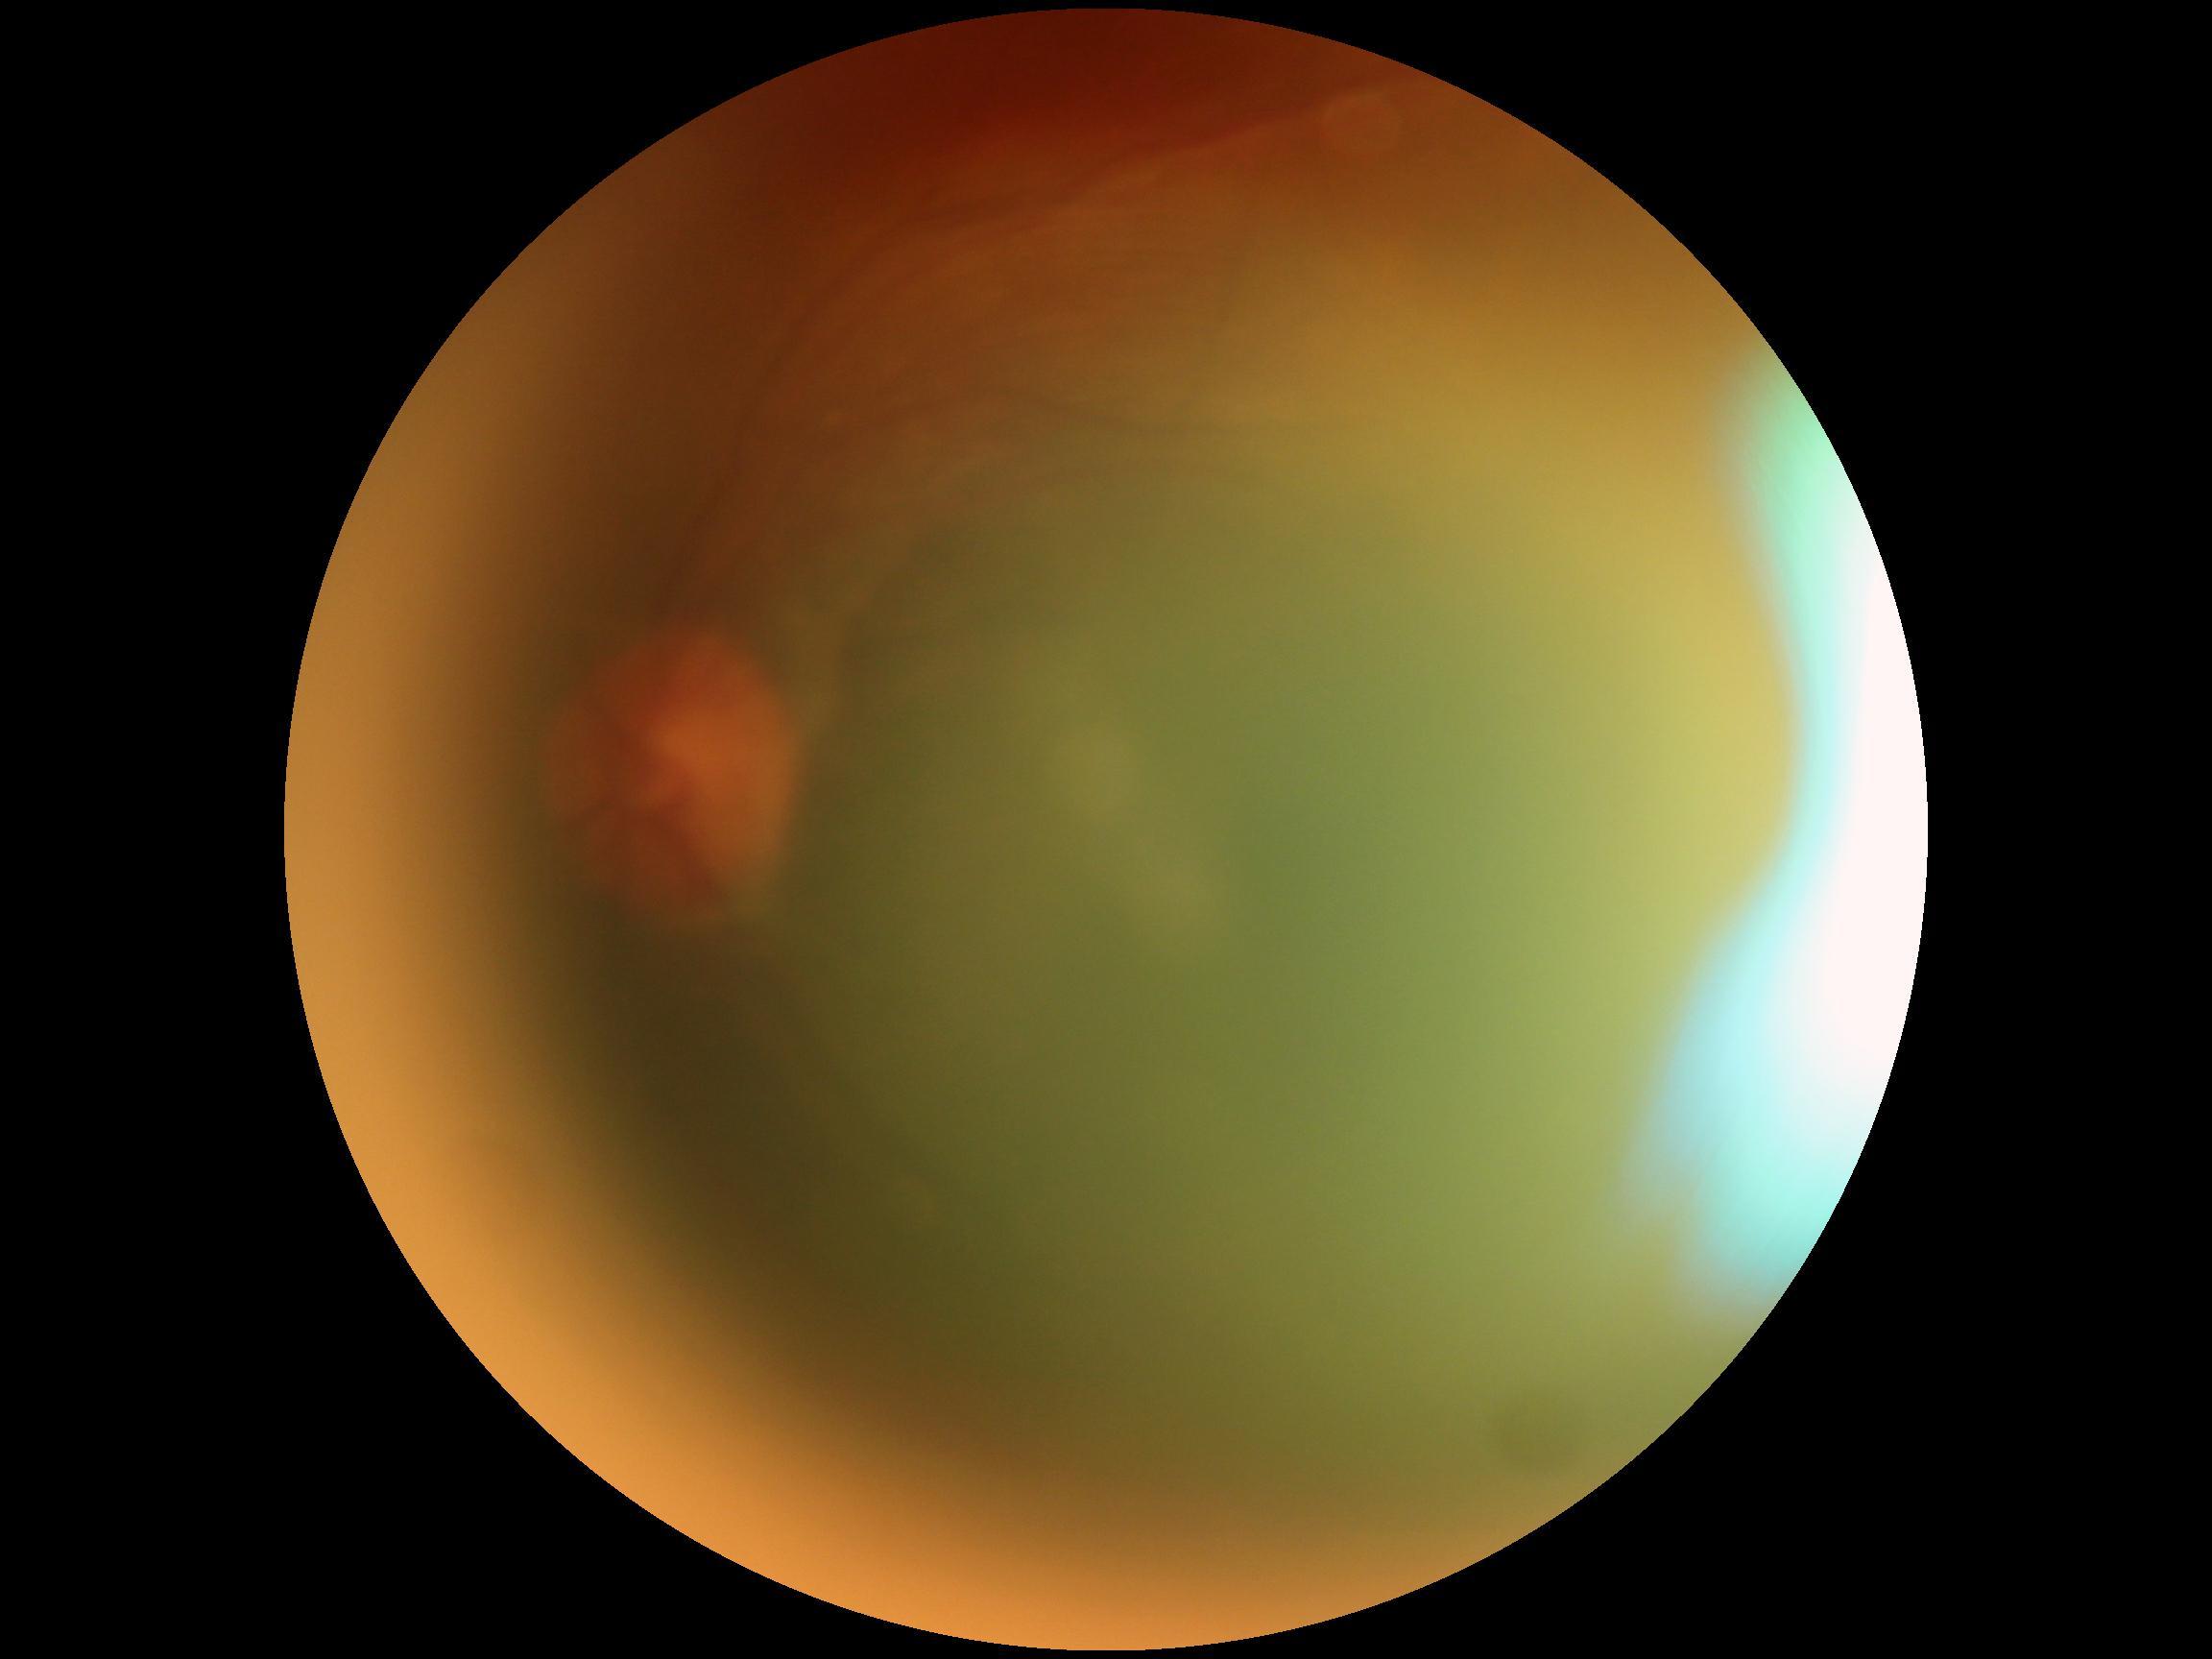
{"dr_grade": "ungradable due to poor image quality"}